45-degree field of view, 848 x 848 pixels
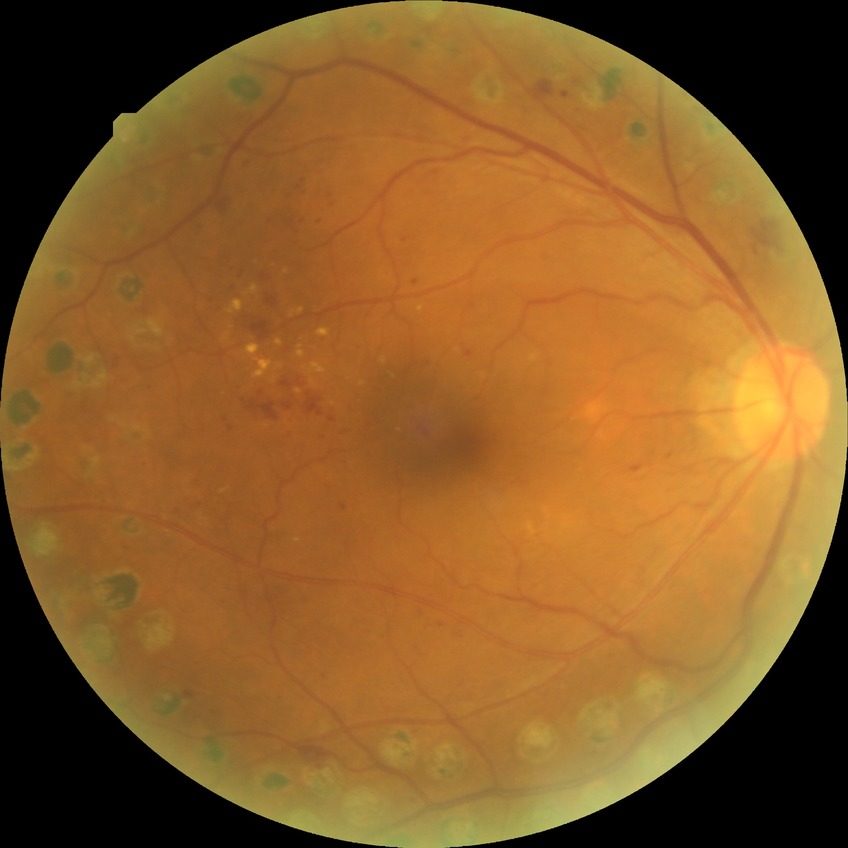 davis_grade: proliferative diabetic retinopathy